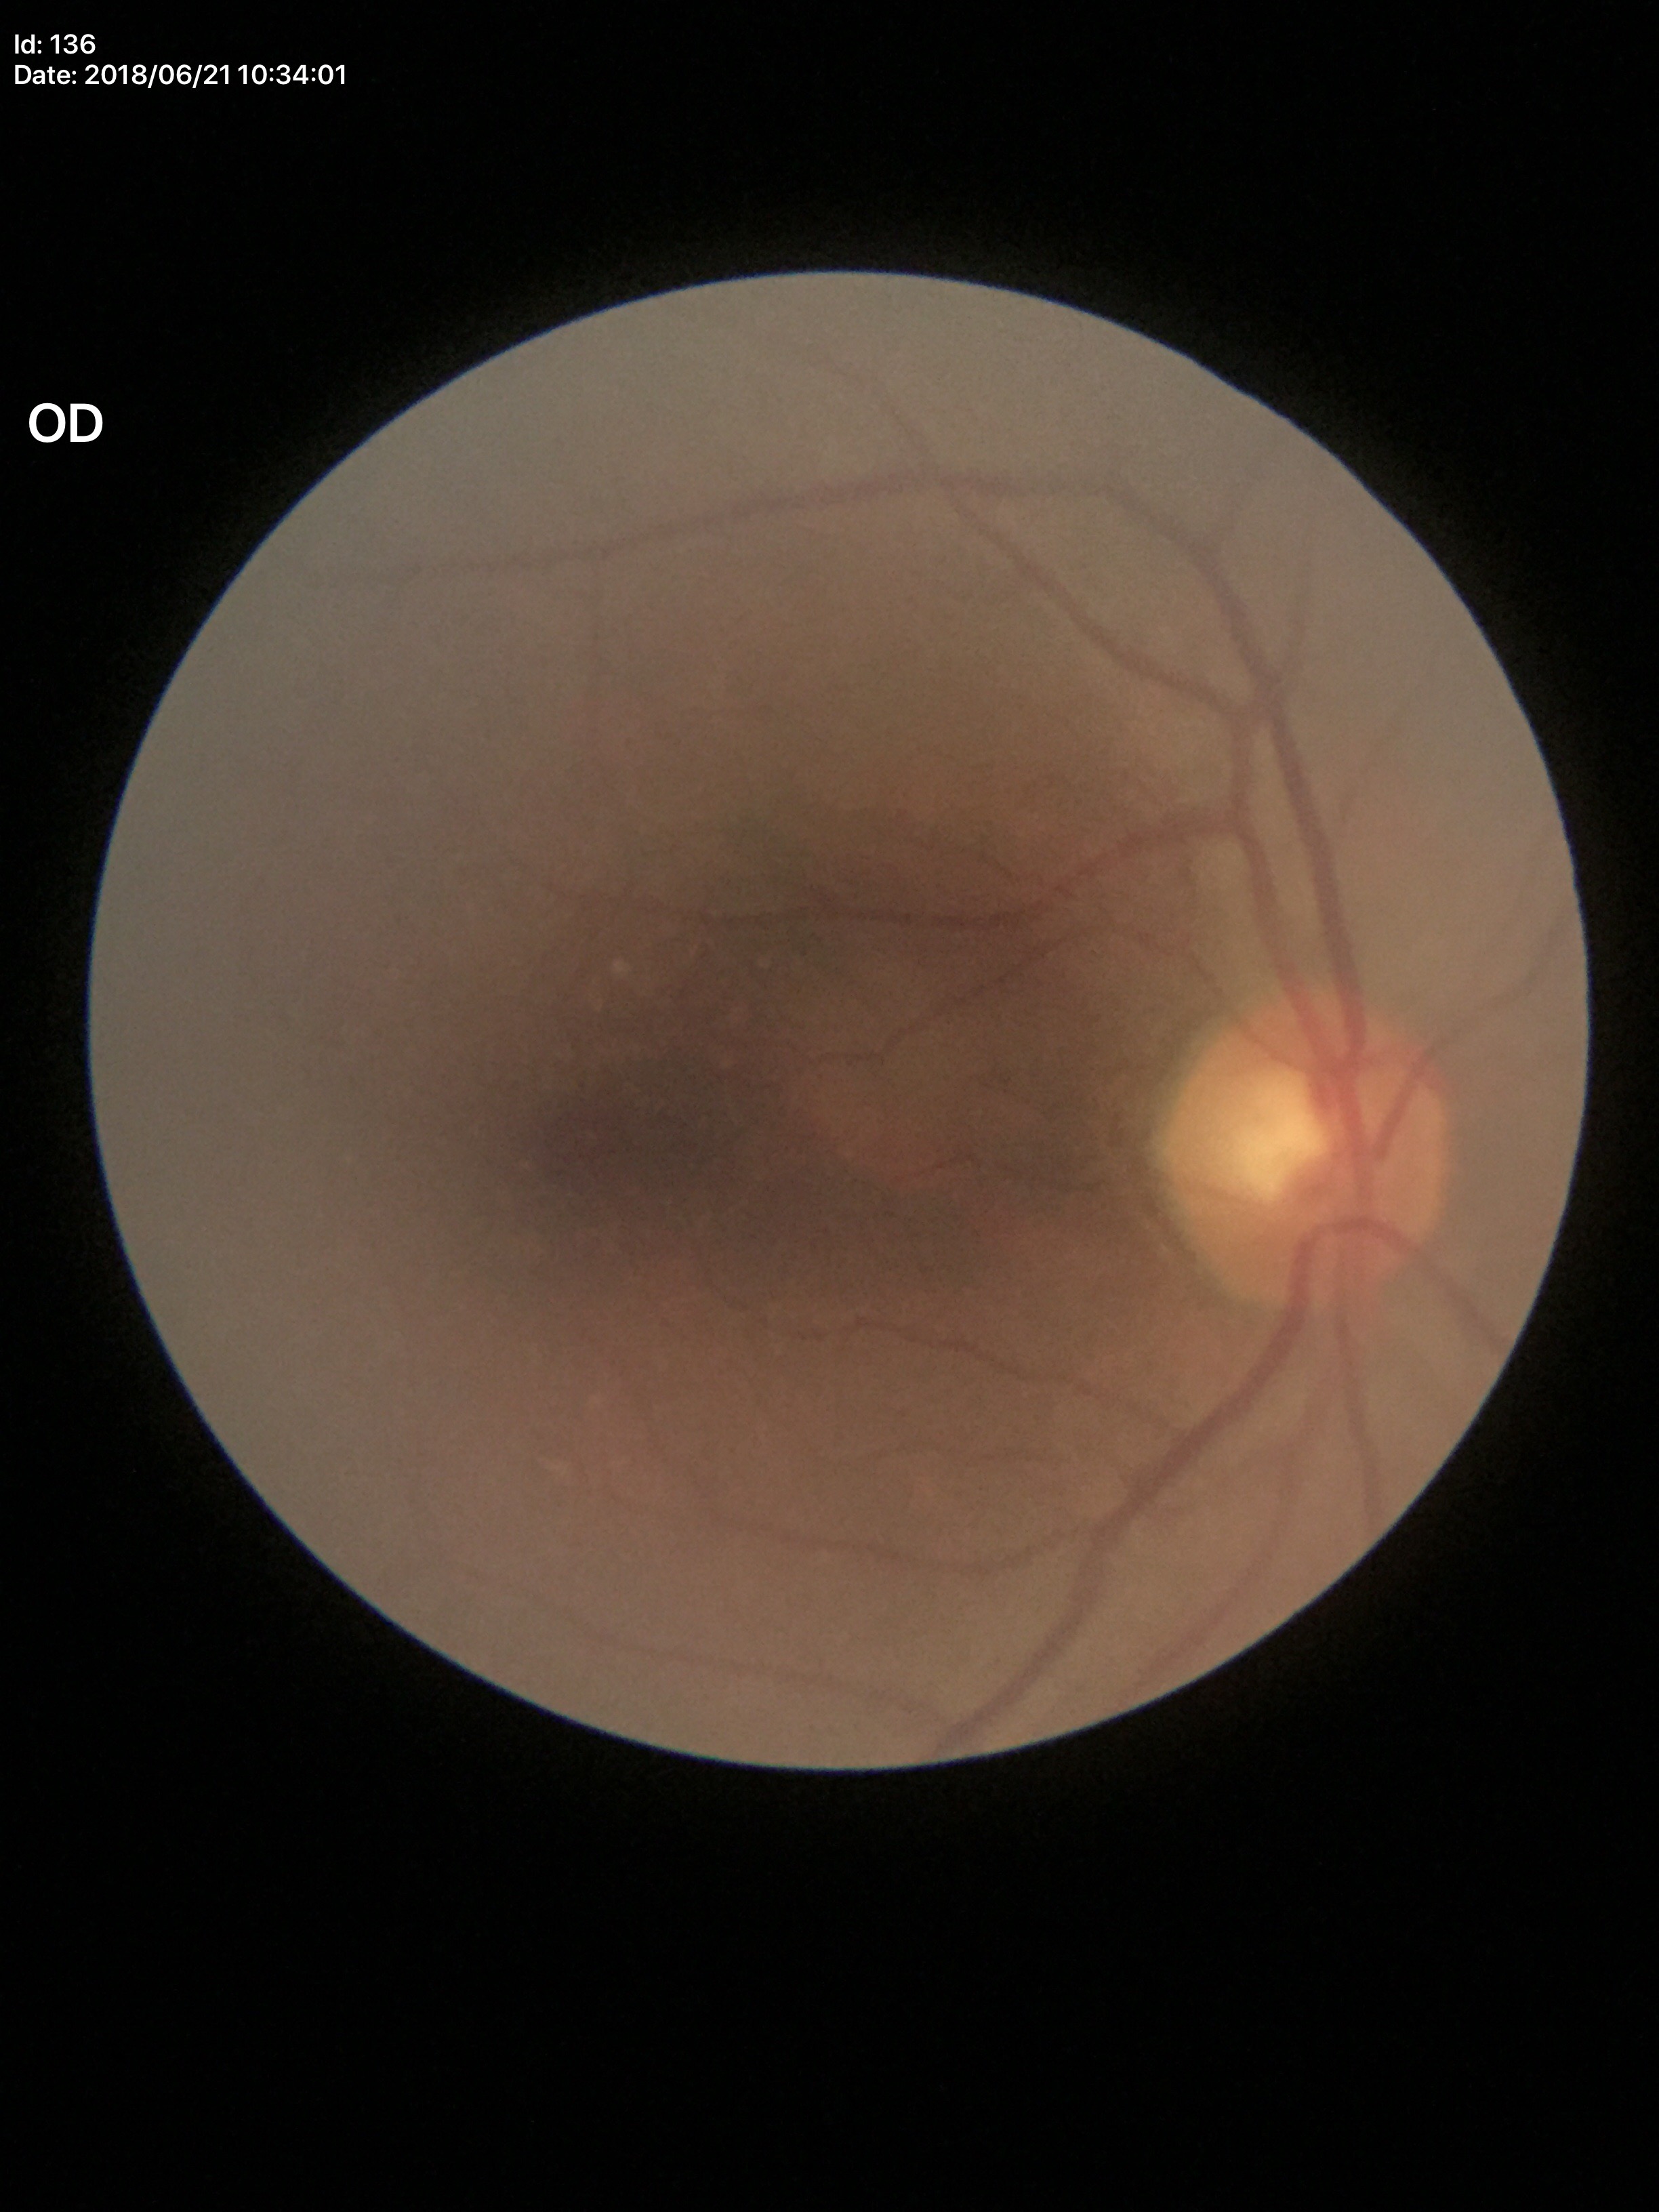 No glaucomatous findings (all 5 graders called normal).
Vertical C/D ratio: 0.53.
Horizontal C/D ratio: 0.54.